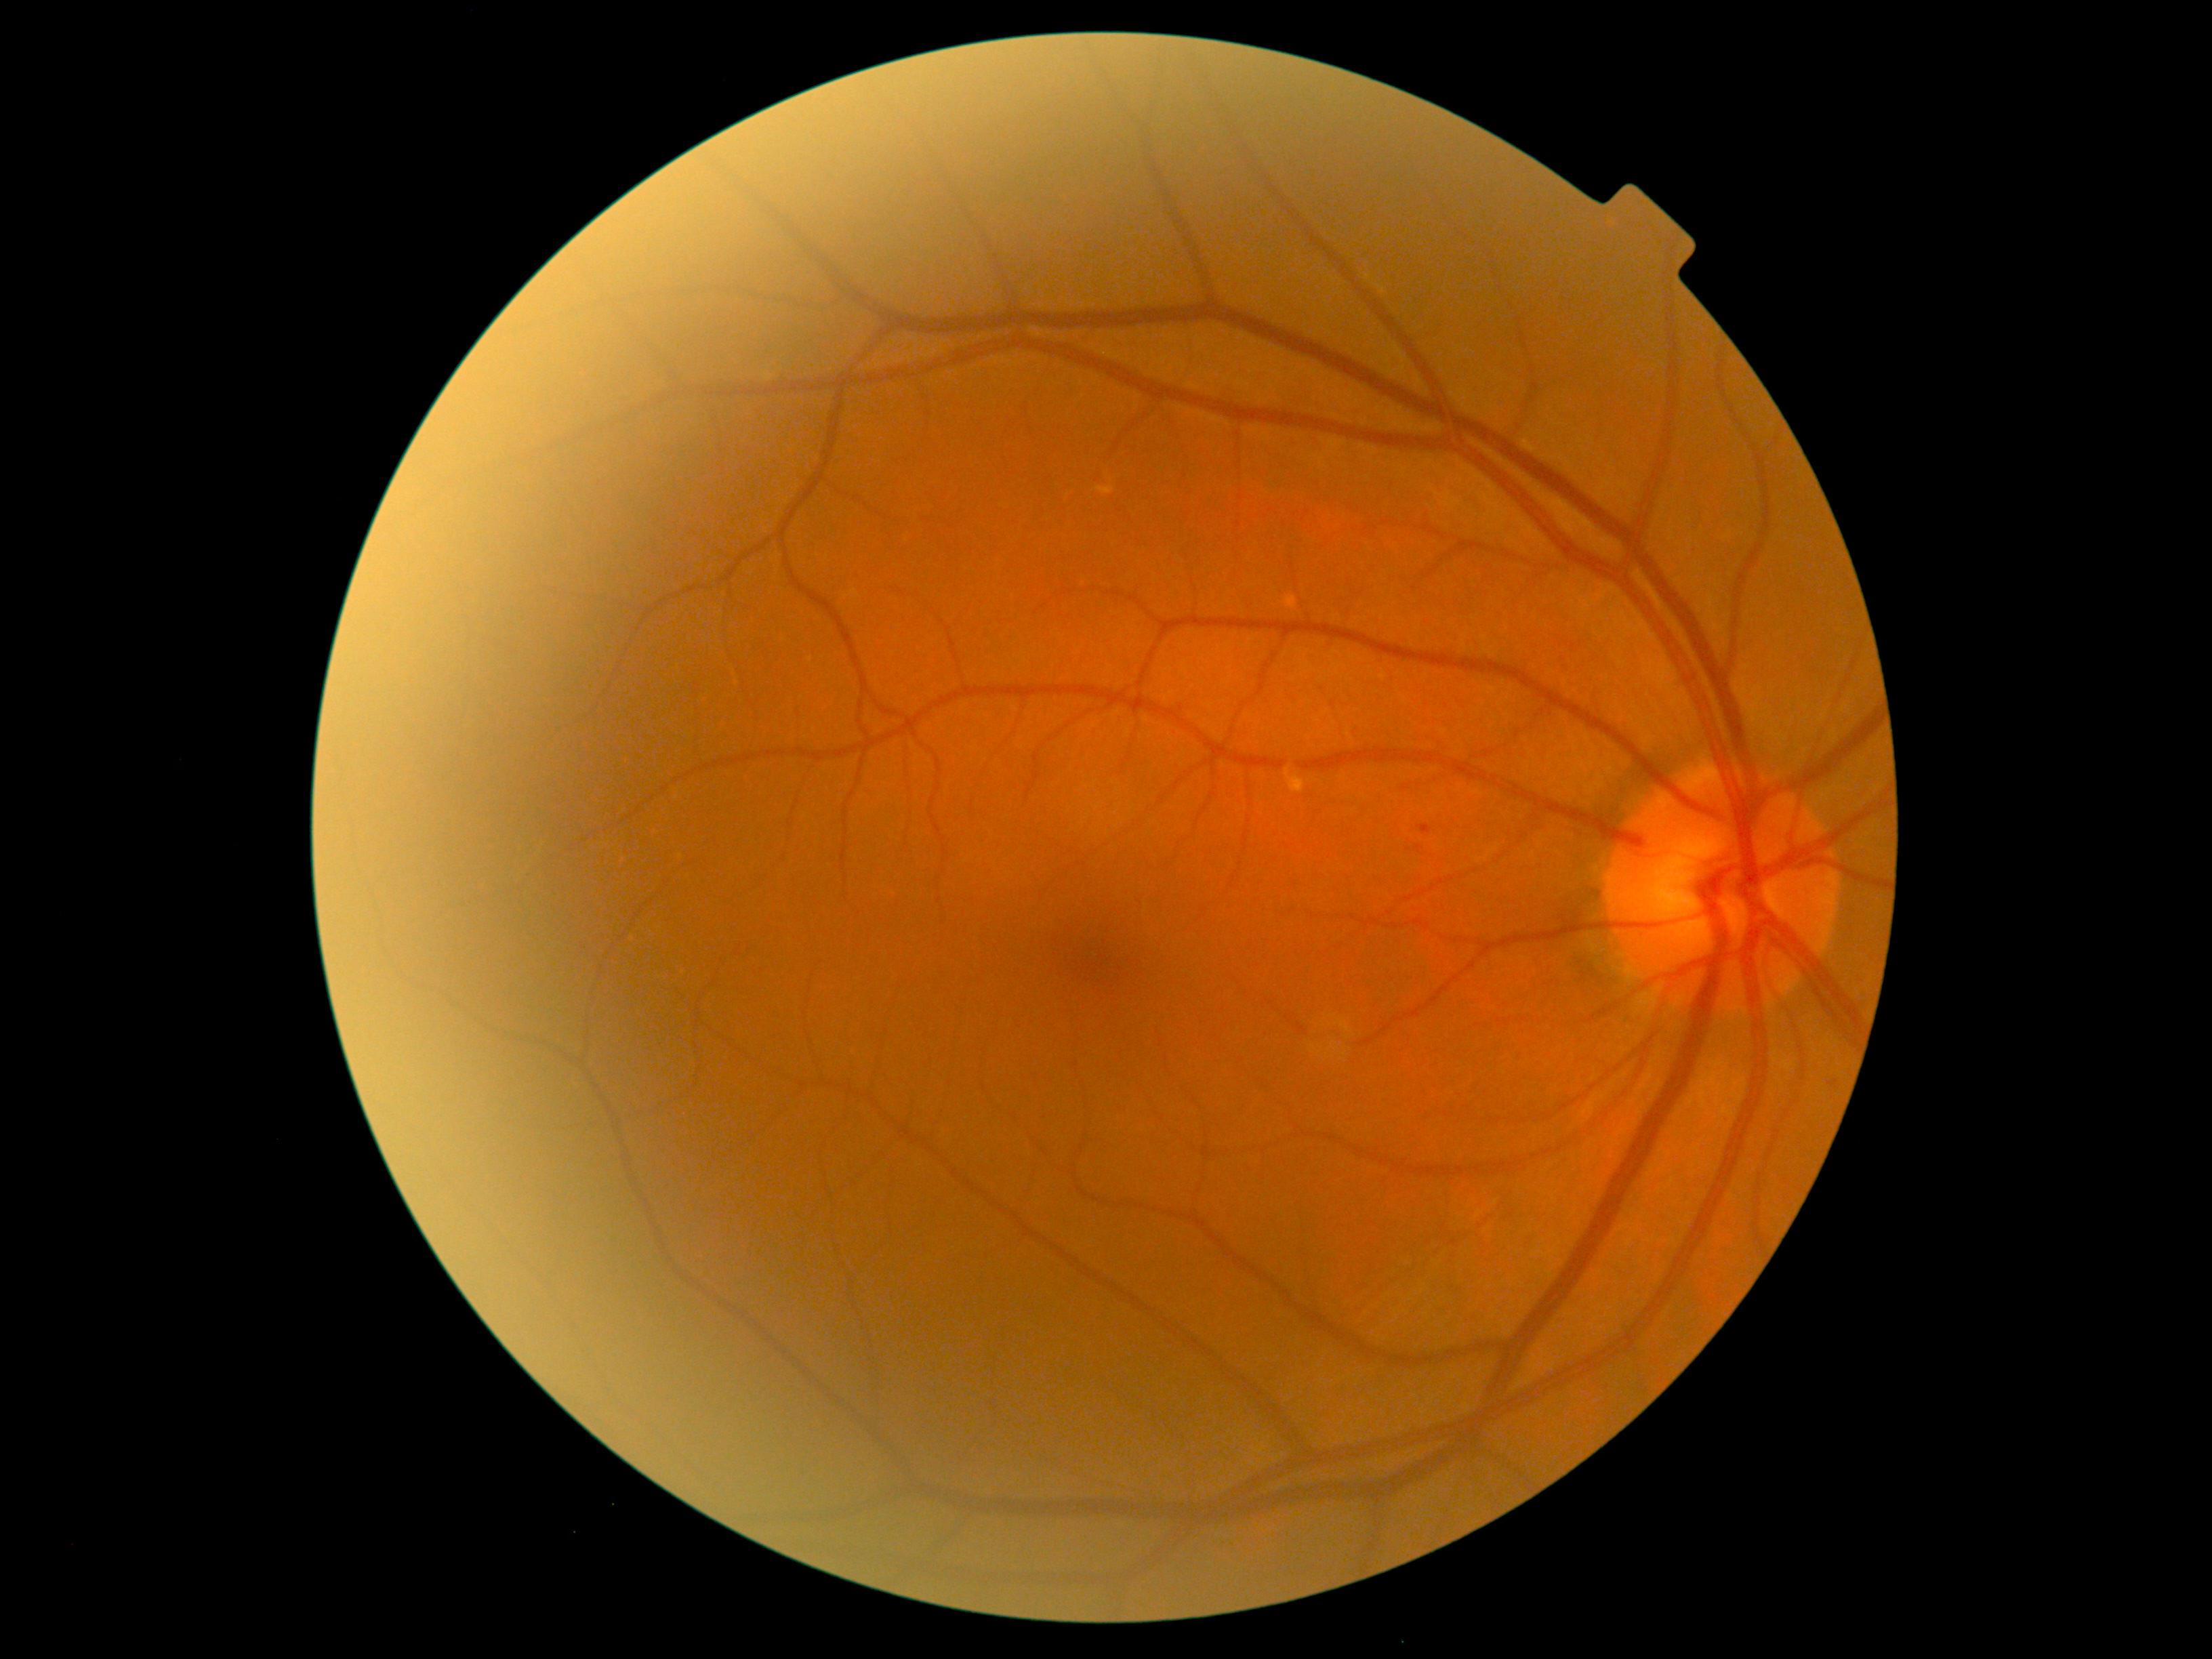
Diabetic retinopathy severity is grade 1 (mild NPDR)
soft exudates = none
microaneurysms = l=1425, t=825, r=1439, b=840; l=1828, t=1080, r=1839, b=1088
hemorrhages = none
hard exudates = none